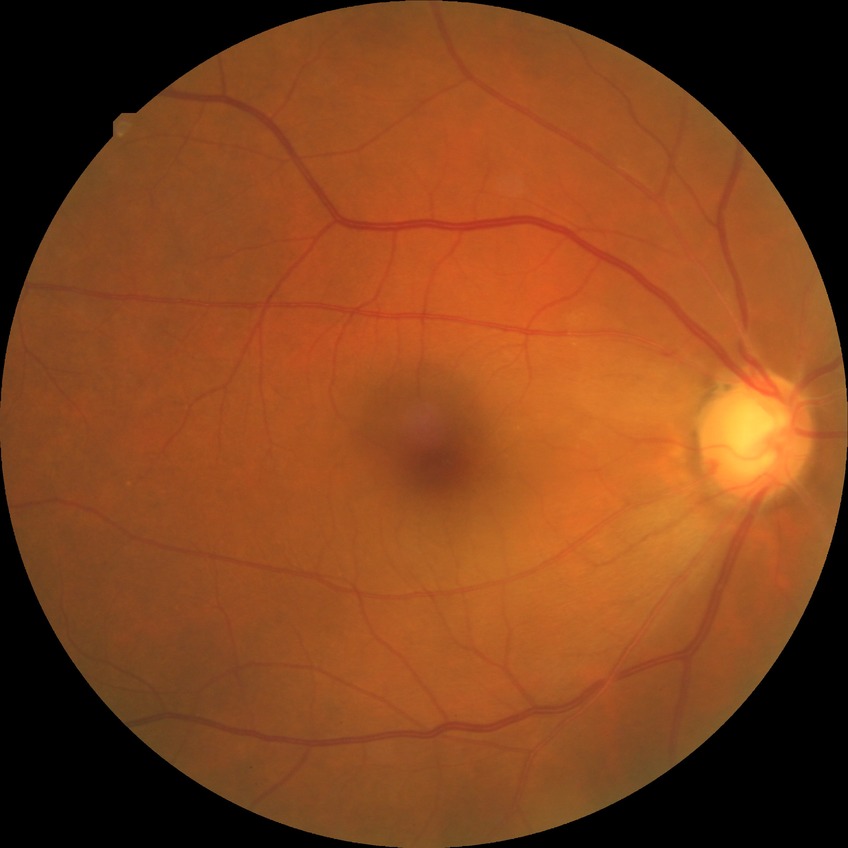
Diabetic retinopathy severity is no diabetic retinopathy.